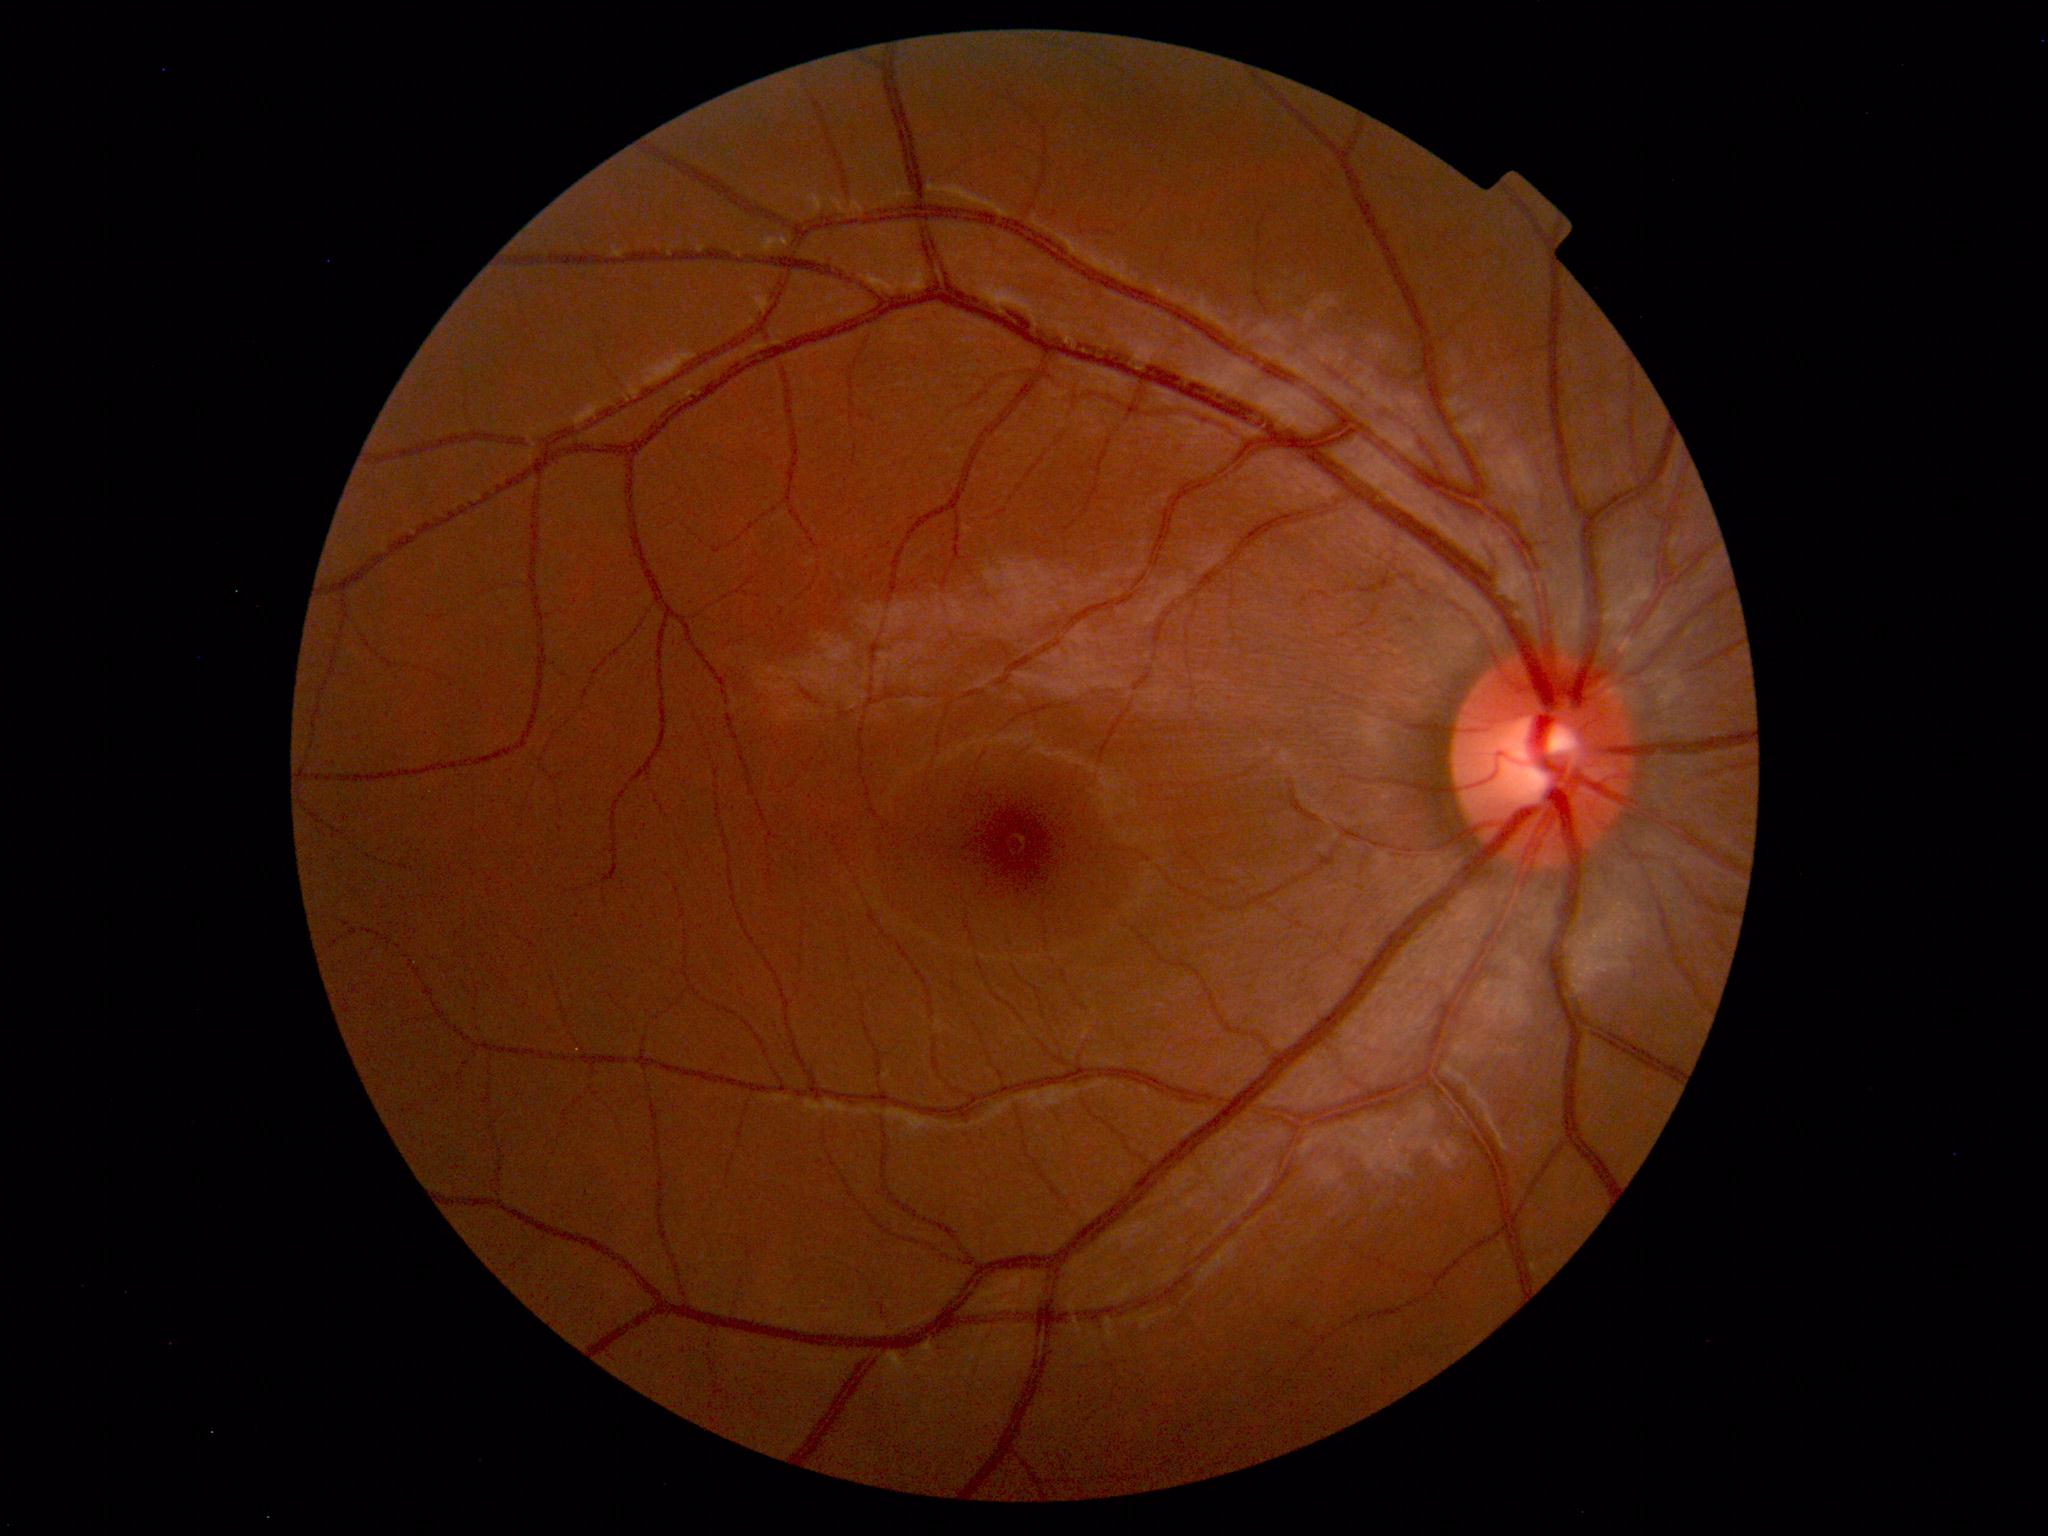
Normal retinal fundus image with no abnormalities identified.